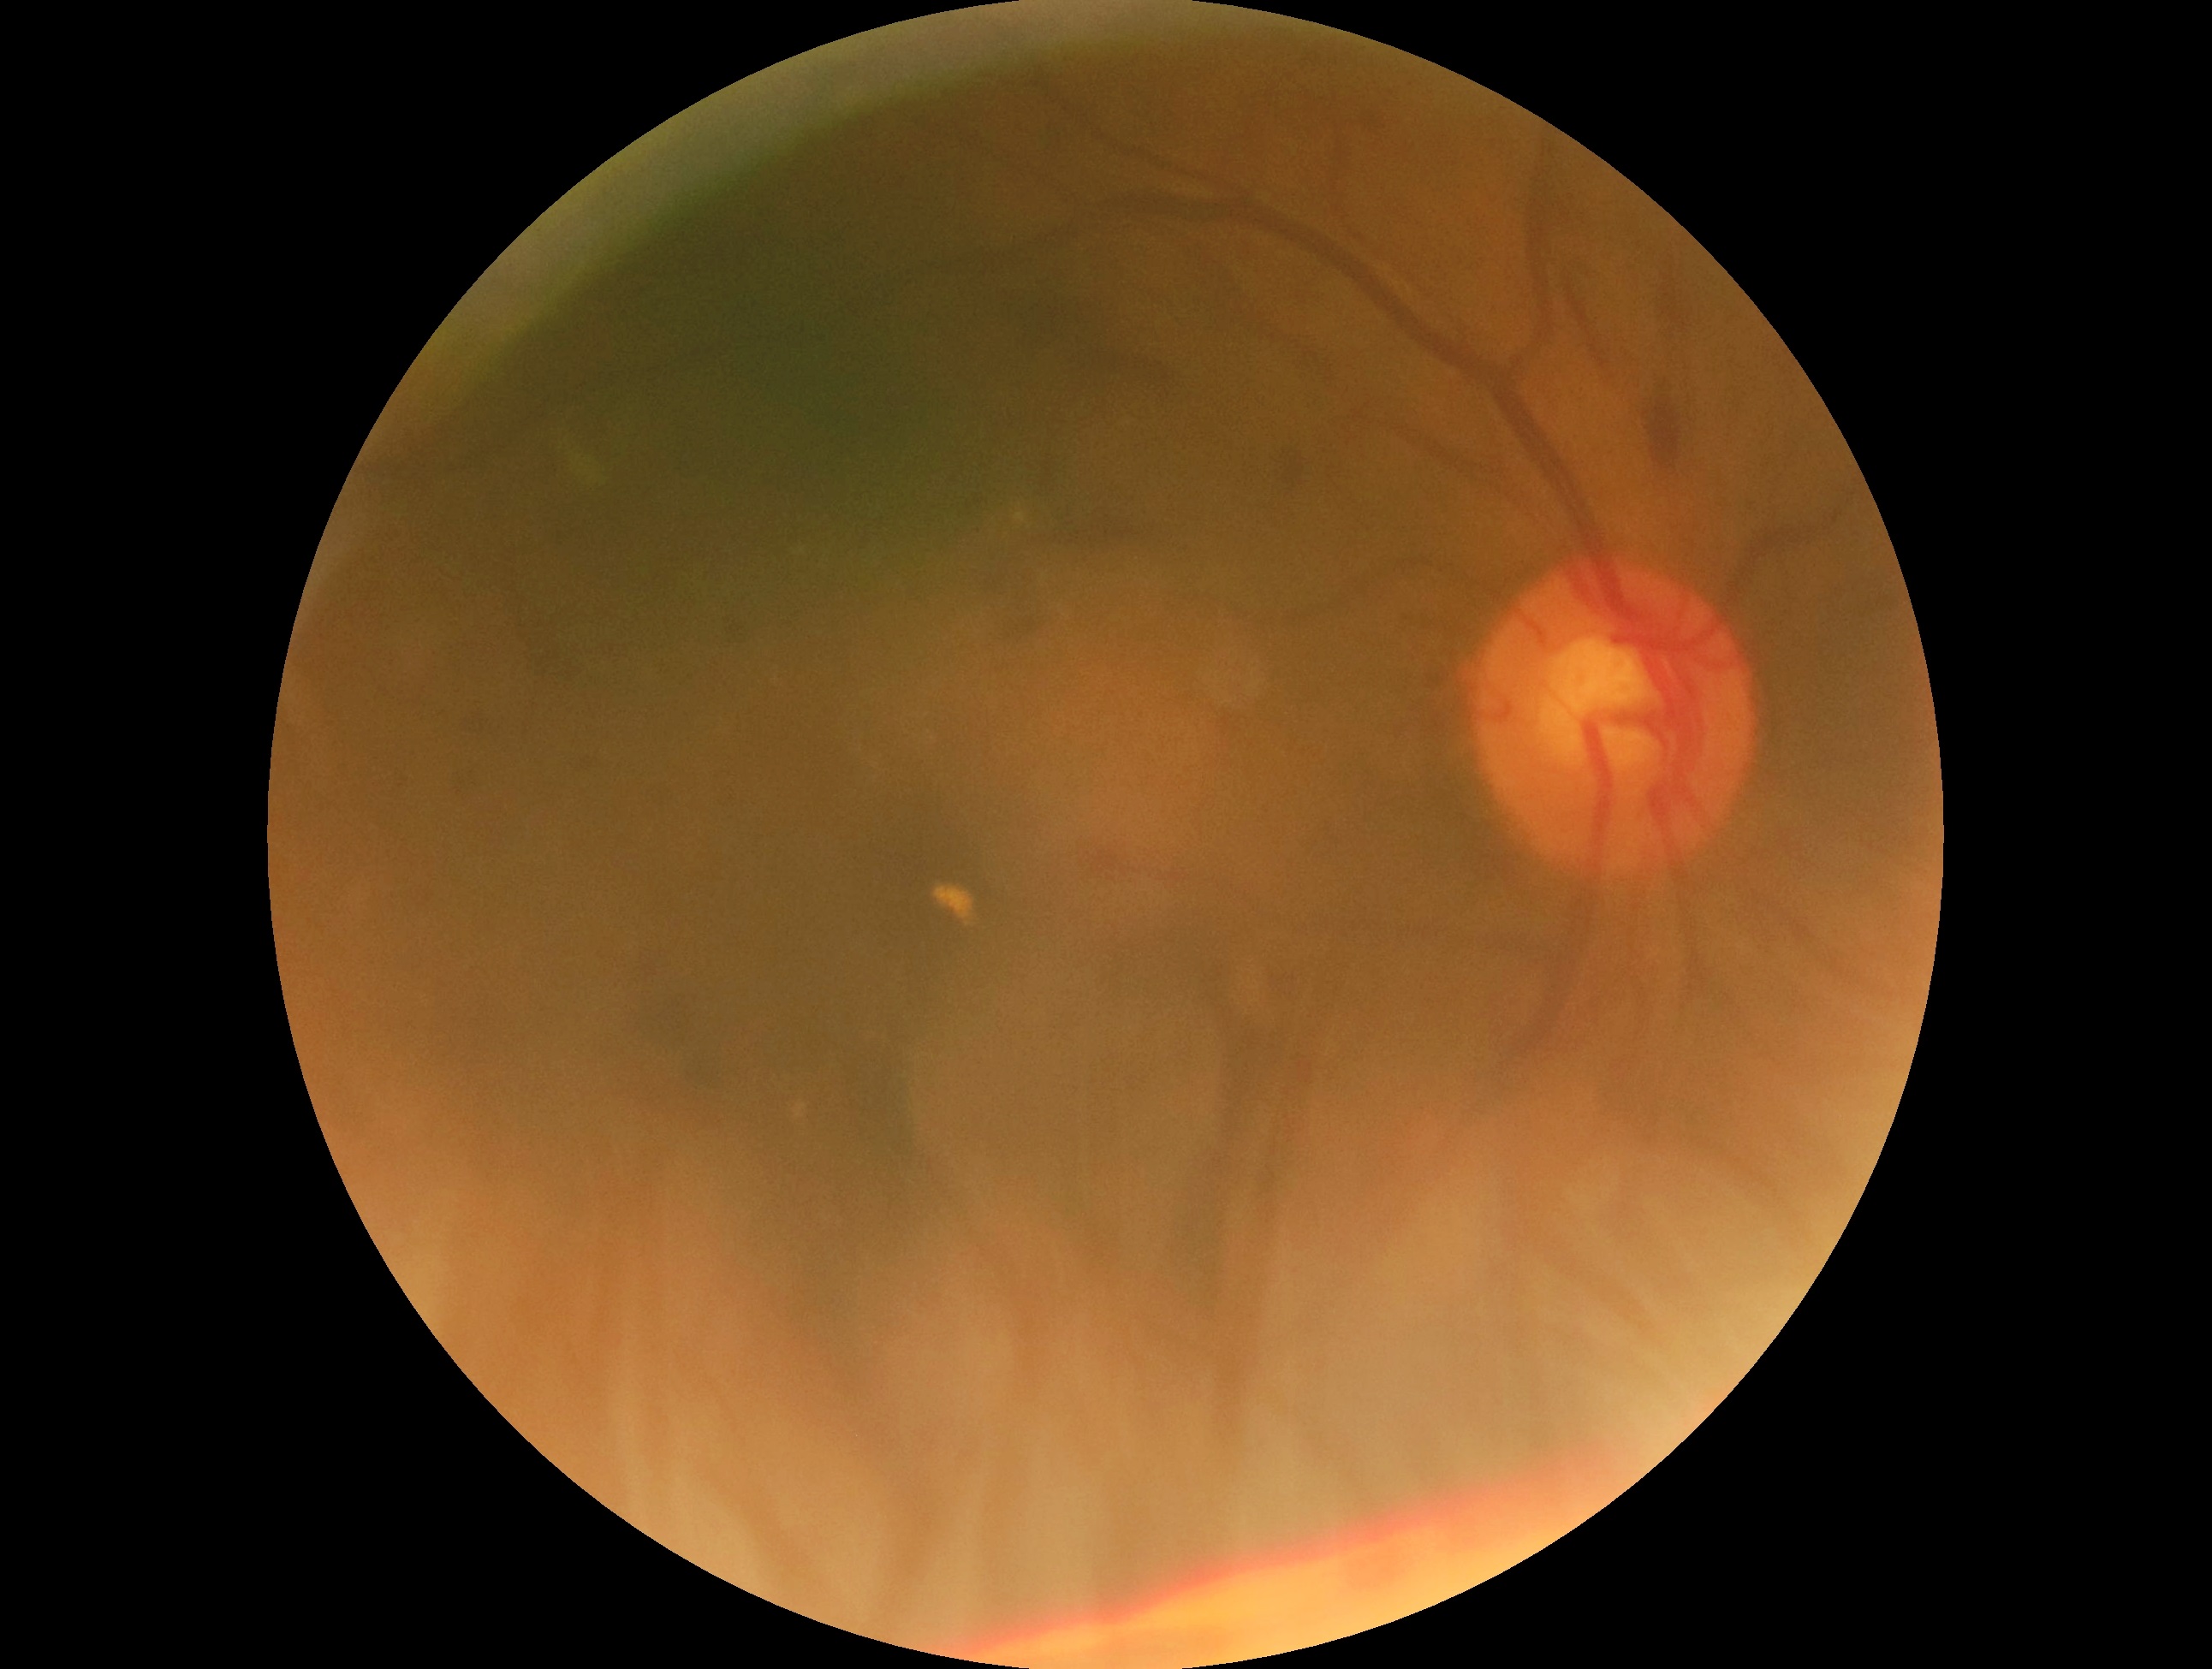   dr_grade: moderate NPDR (grade 2)